2048x1536. FOV: 45 degrees — 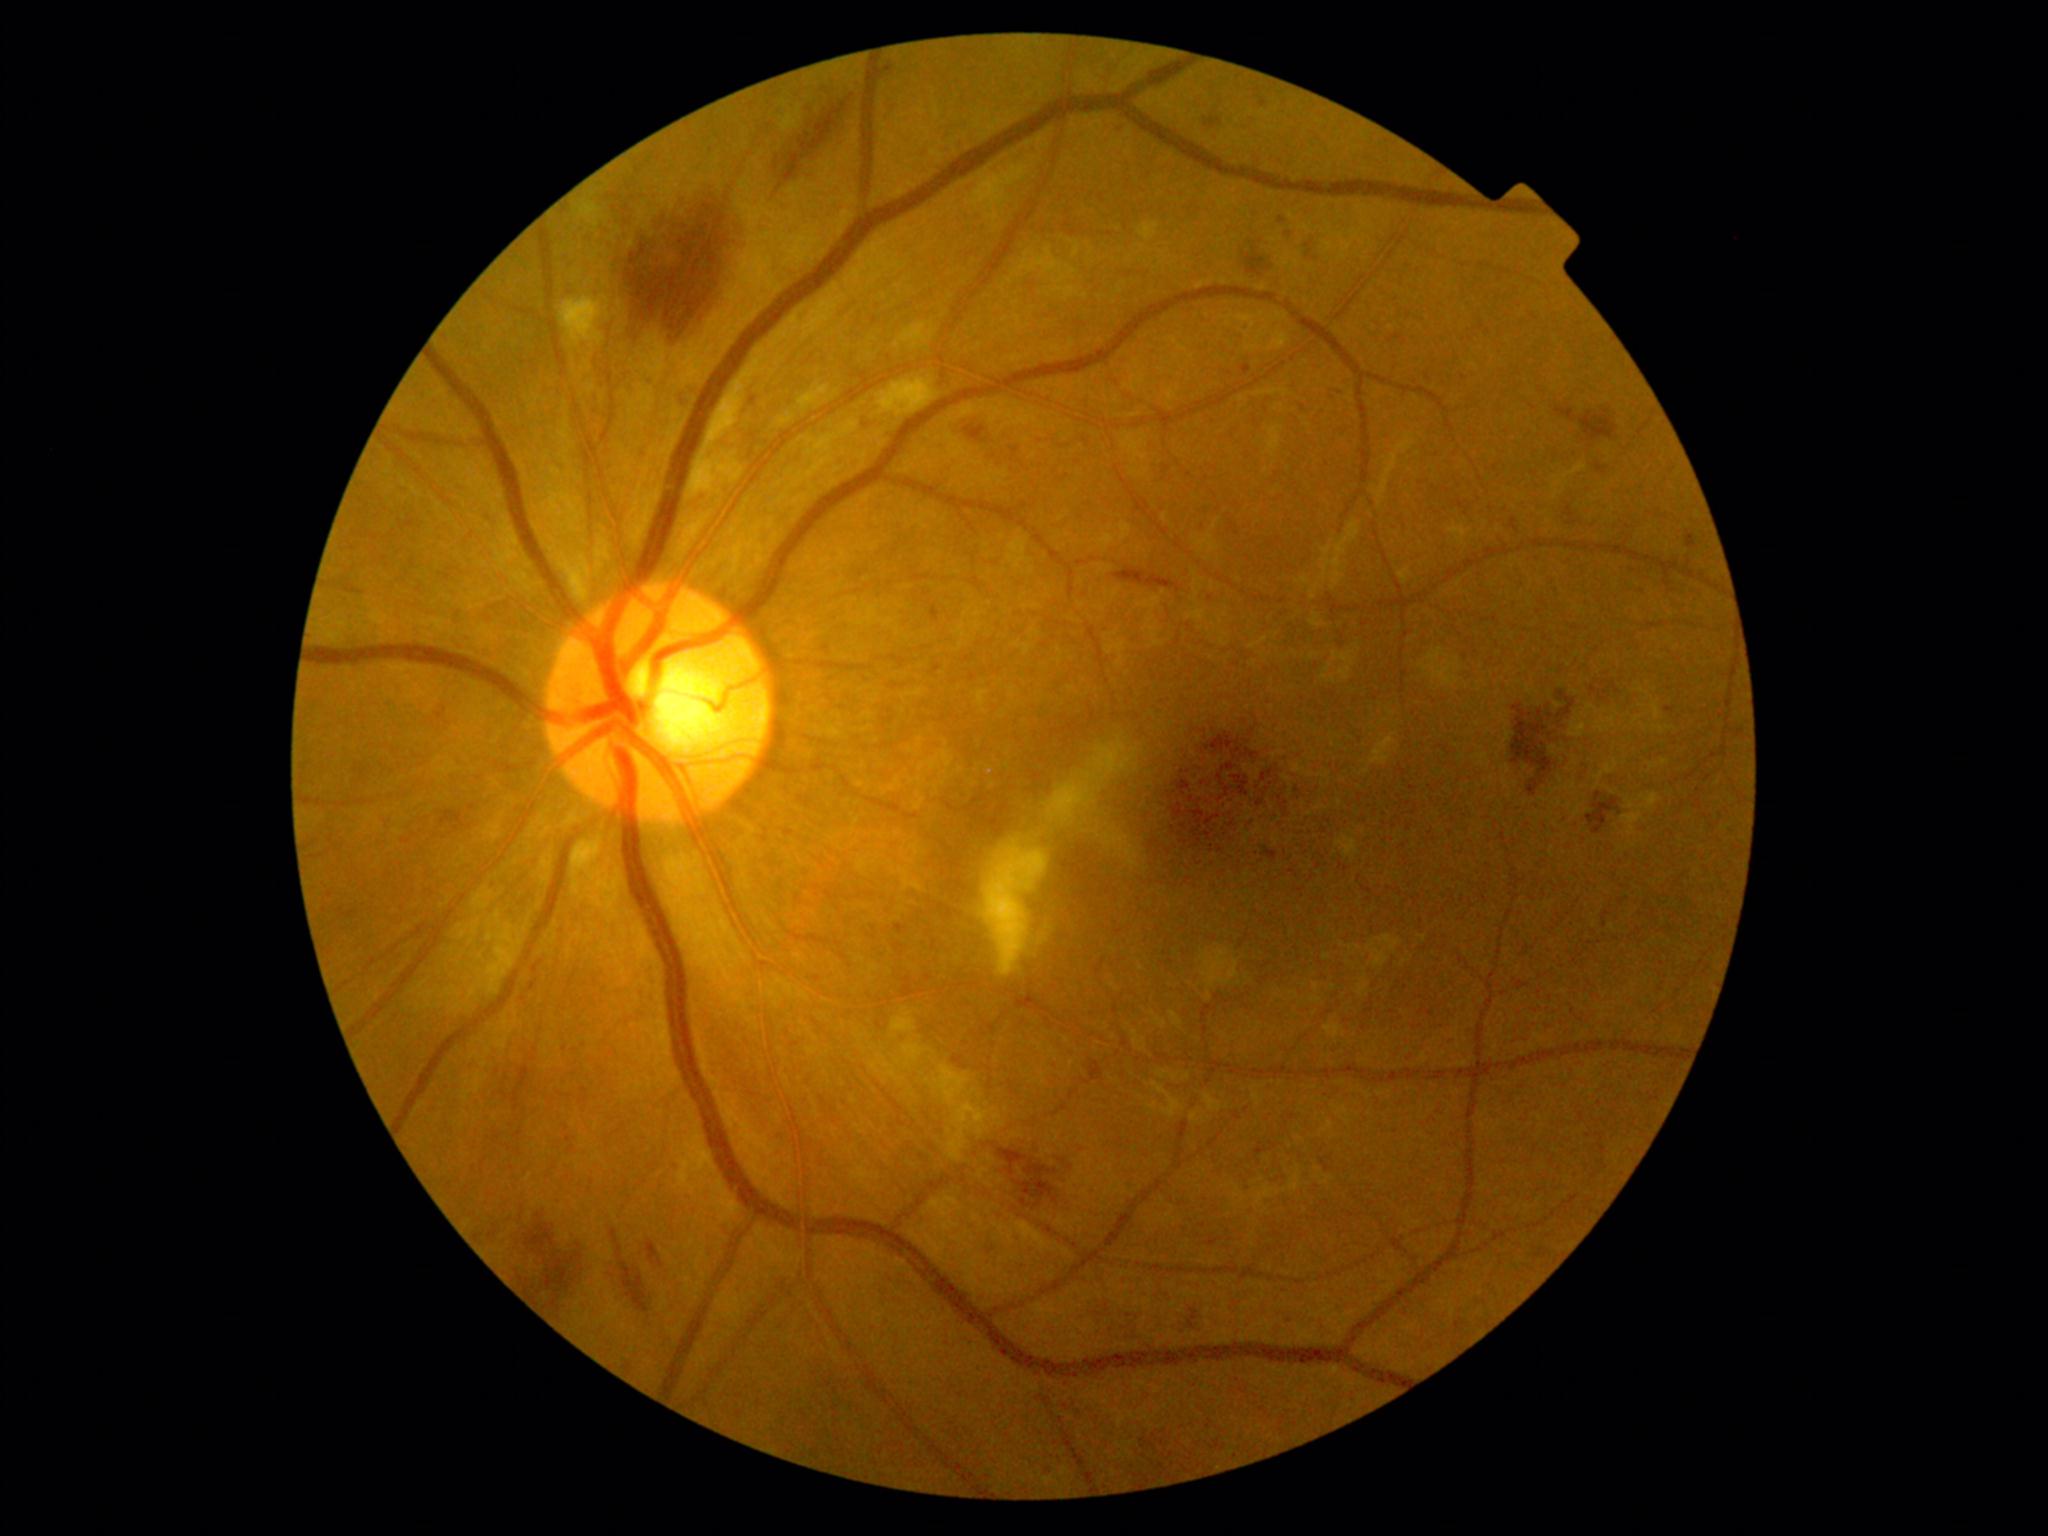

retinopathy grade: 2 (moderate NPDR) — more than just microaneurysms but less than severe NPDR.